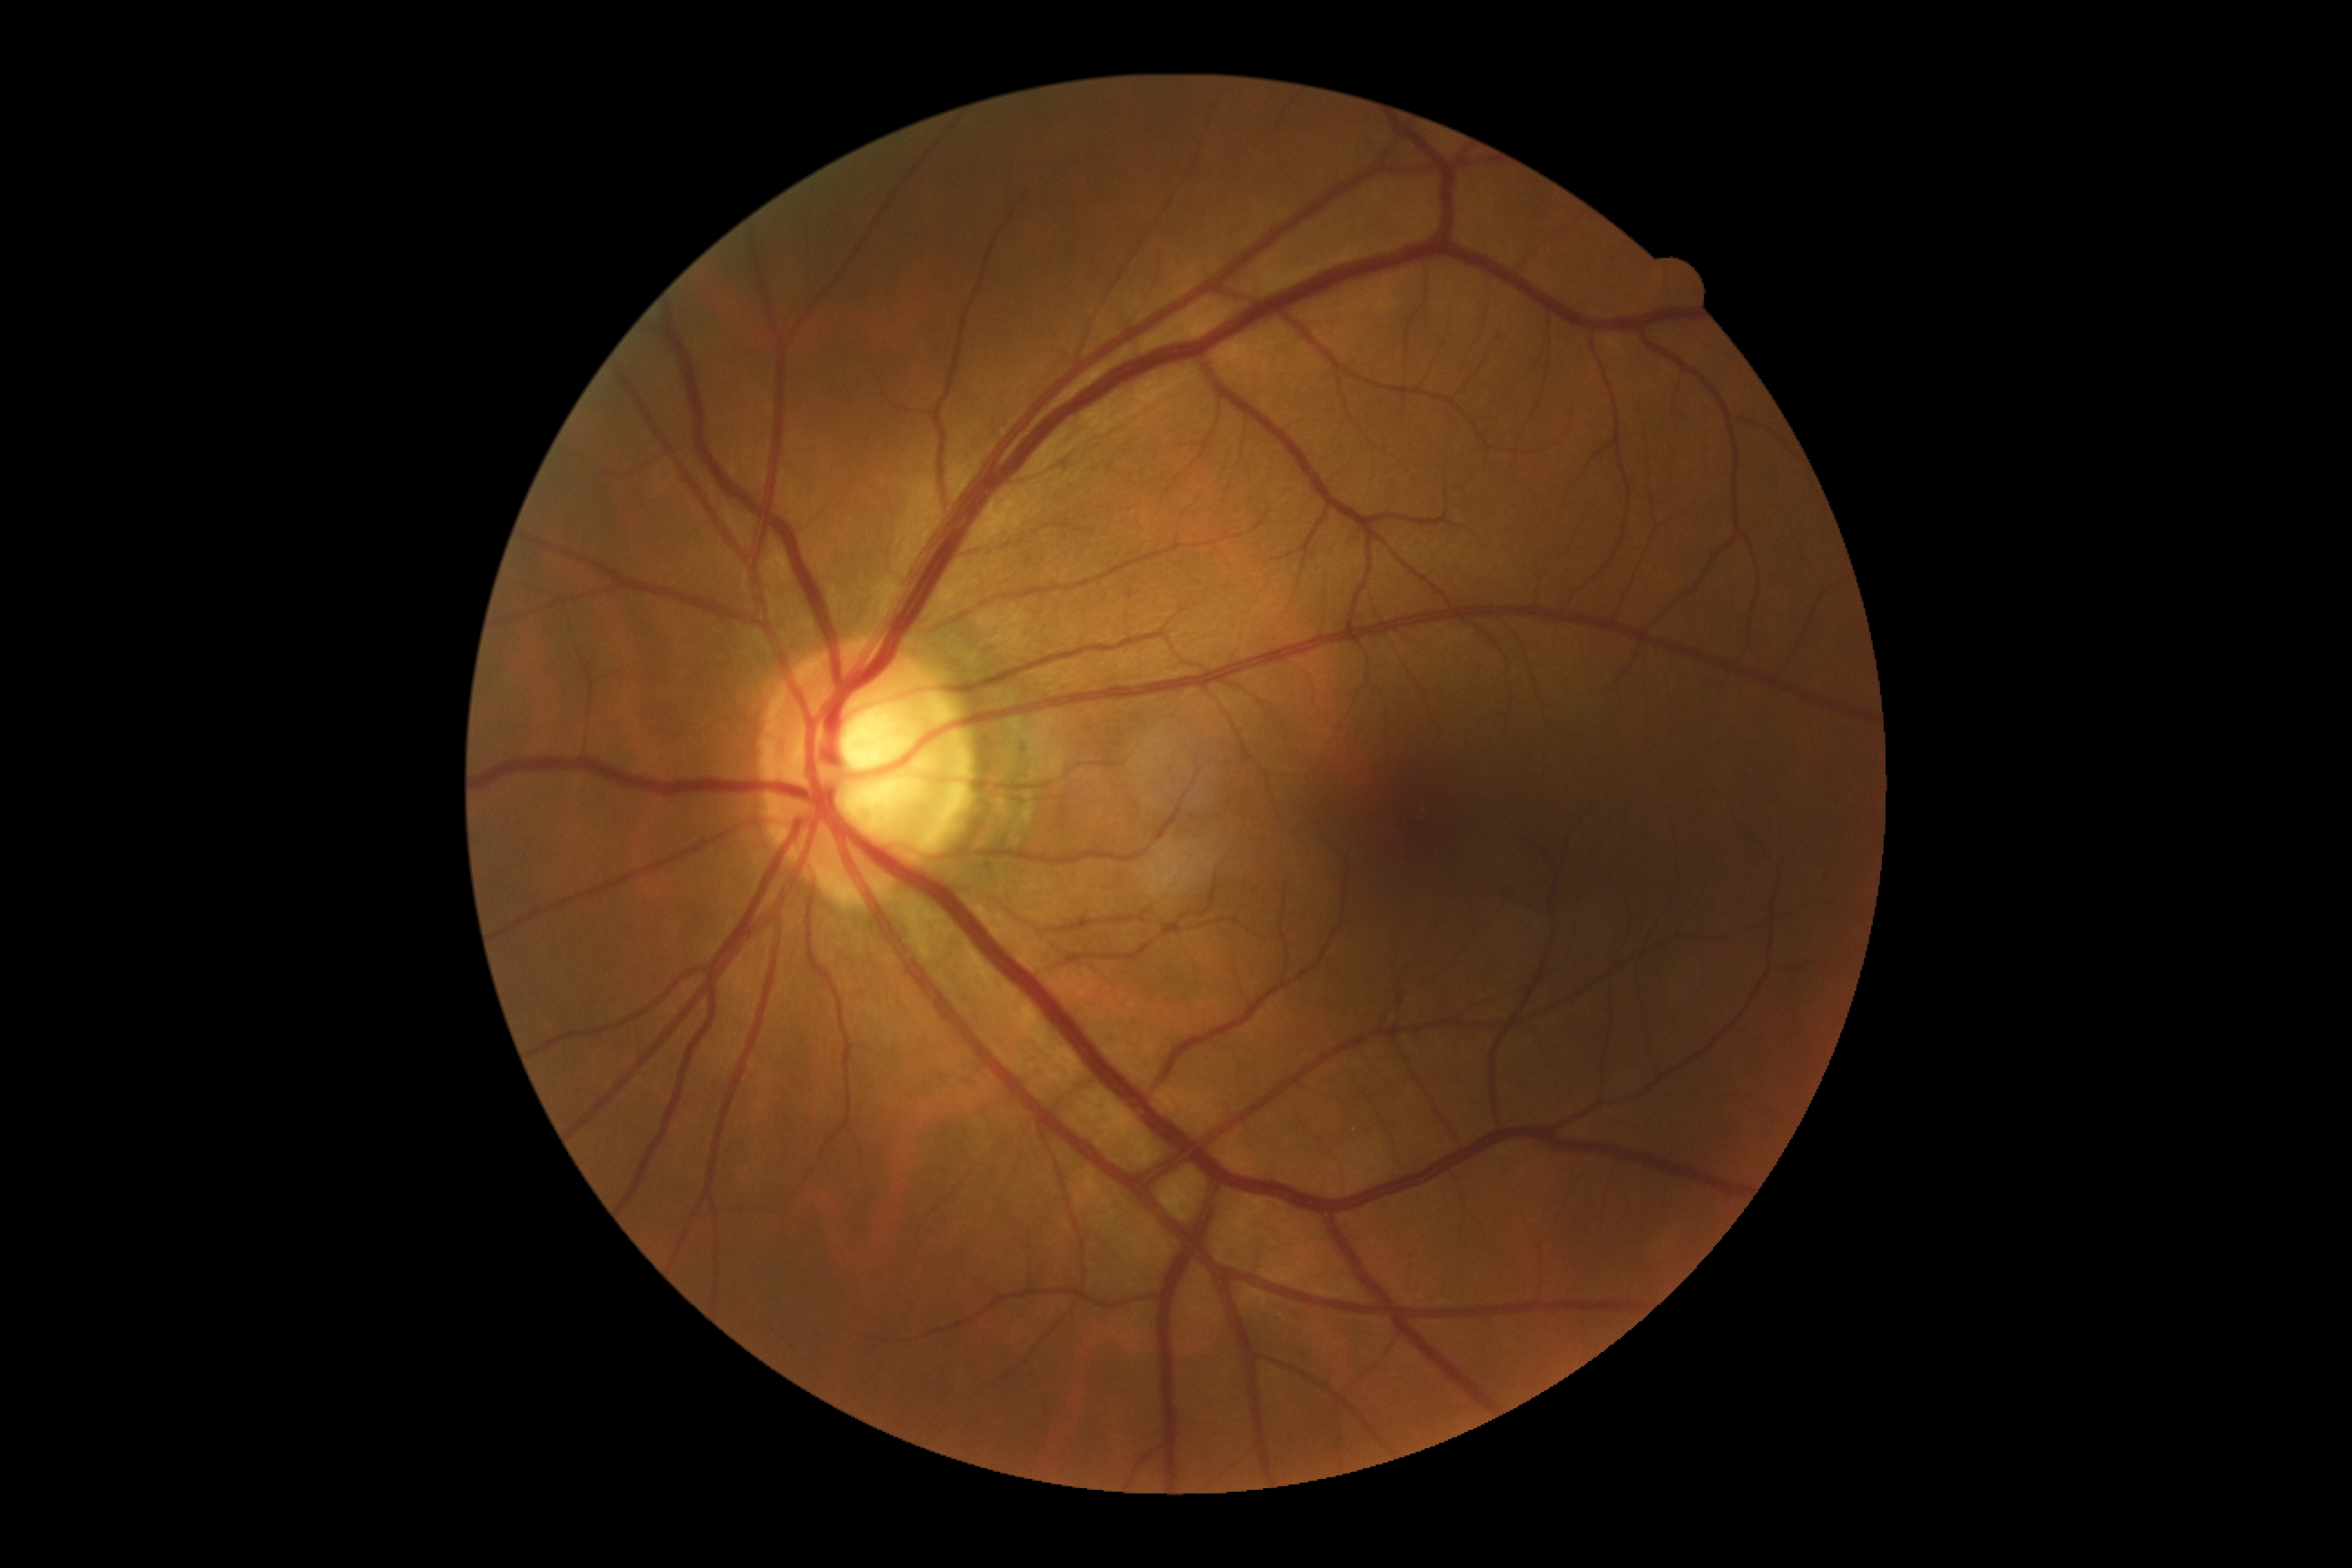

dr_grade: 0 (no apparent retinopathy)